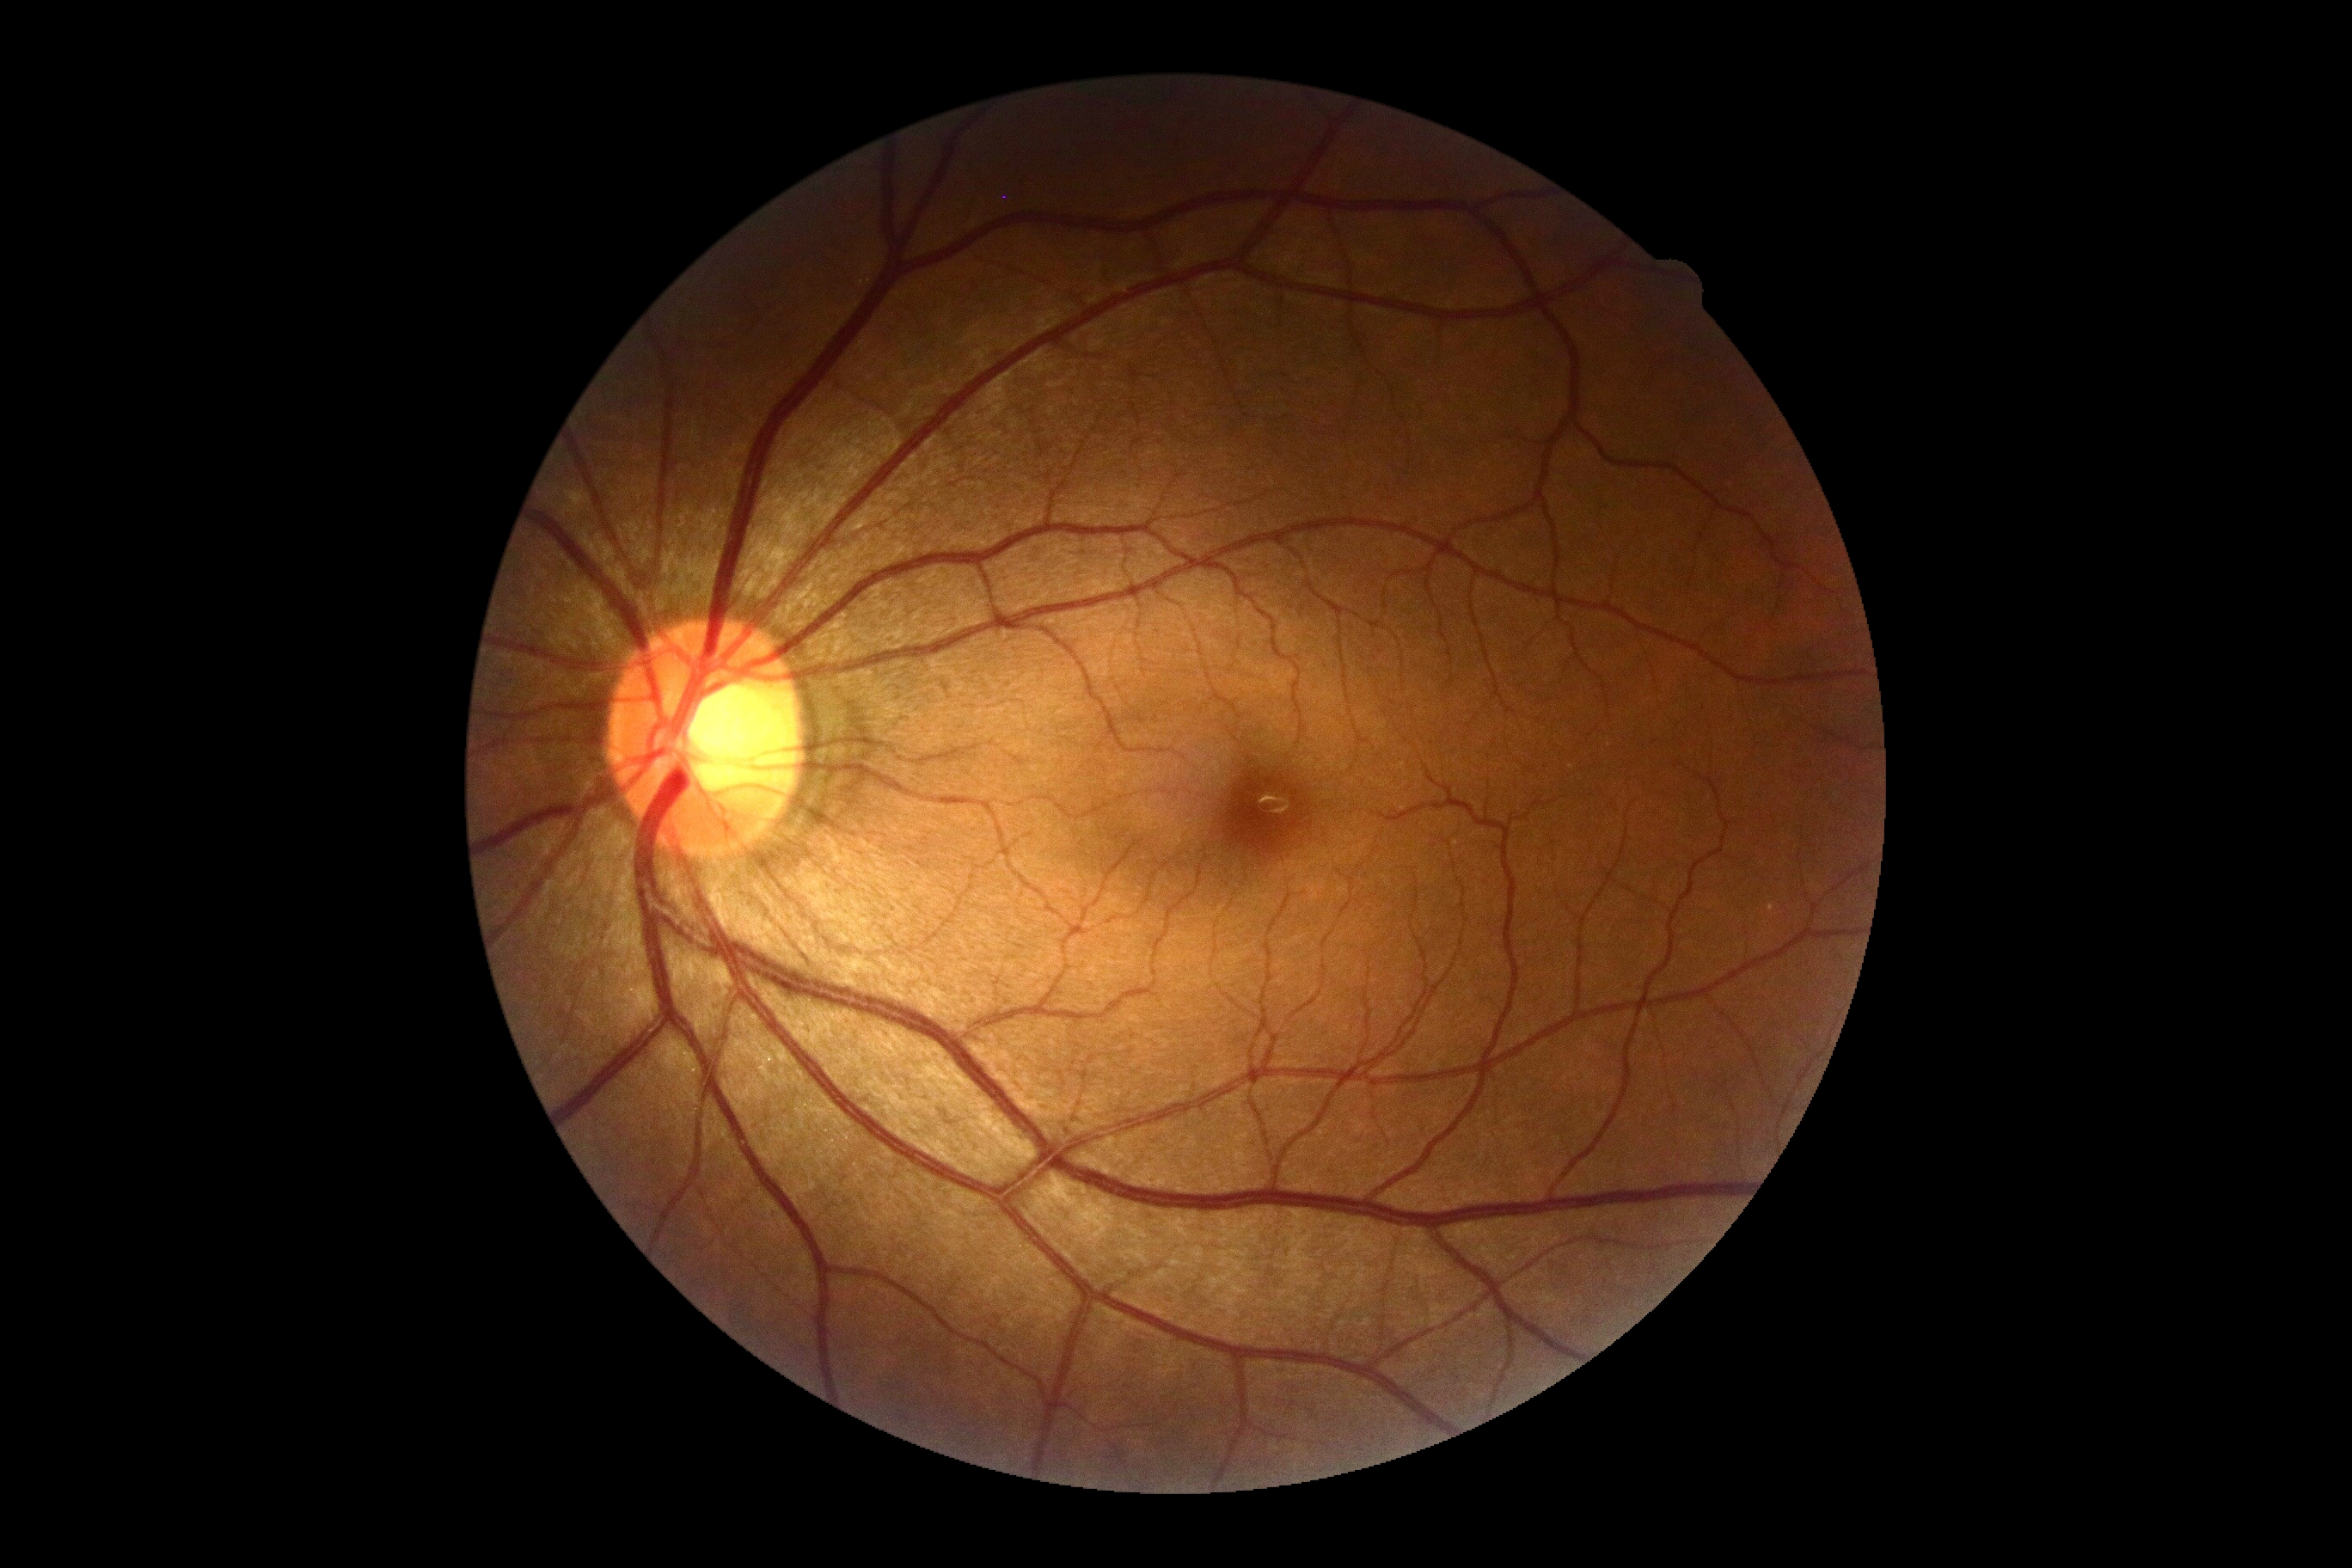 Diabetic retinopathy severity: grade 0 — no visible signs of diabetic retinopathy.